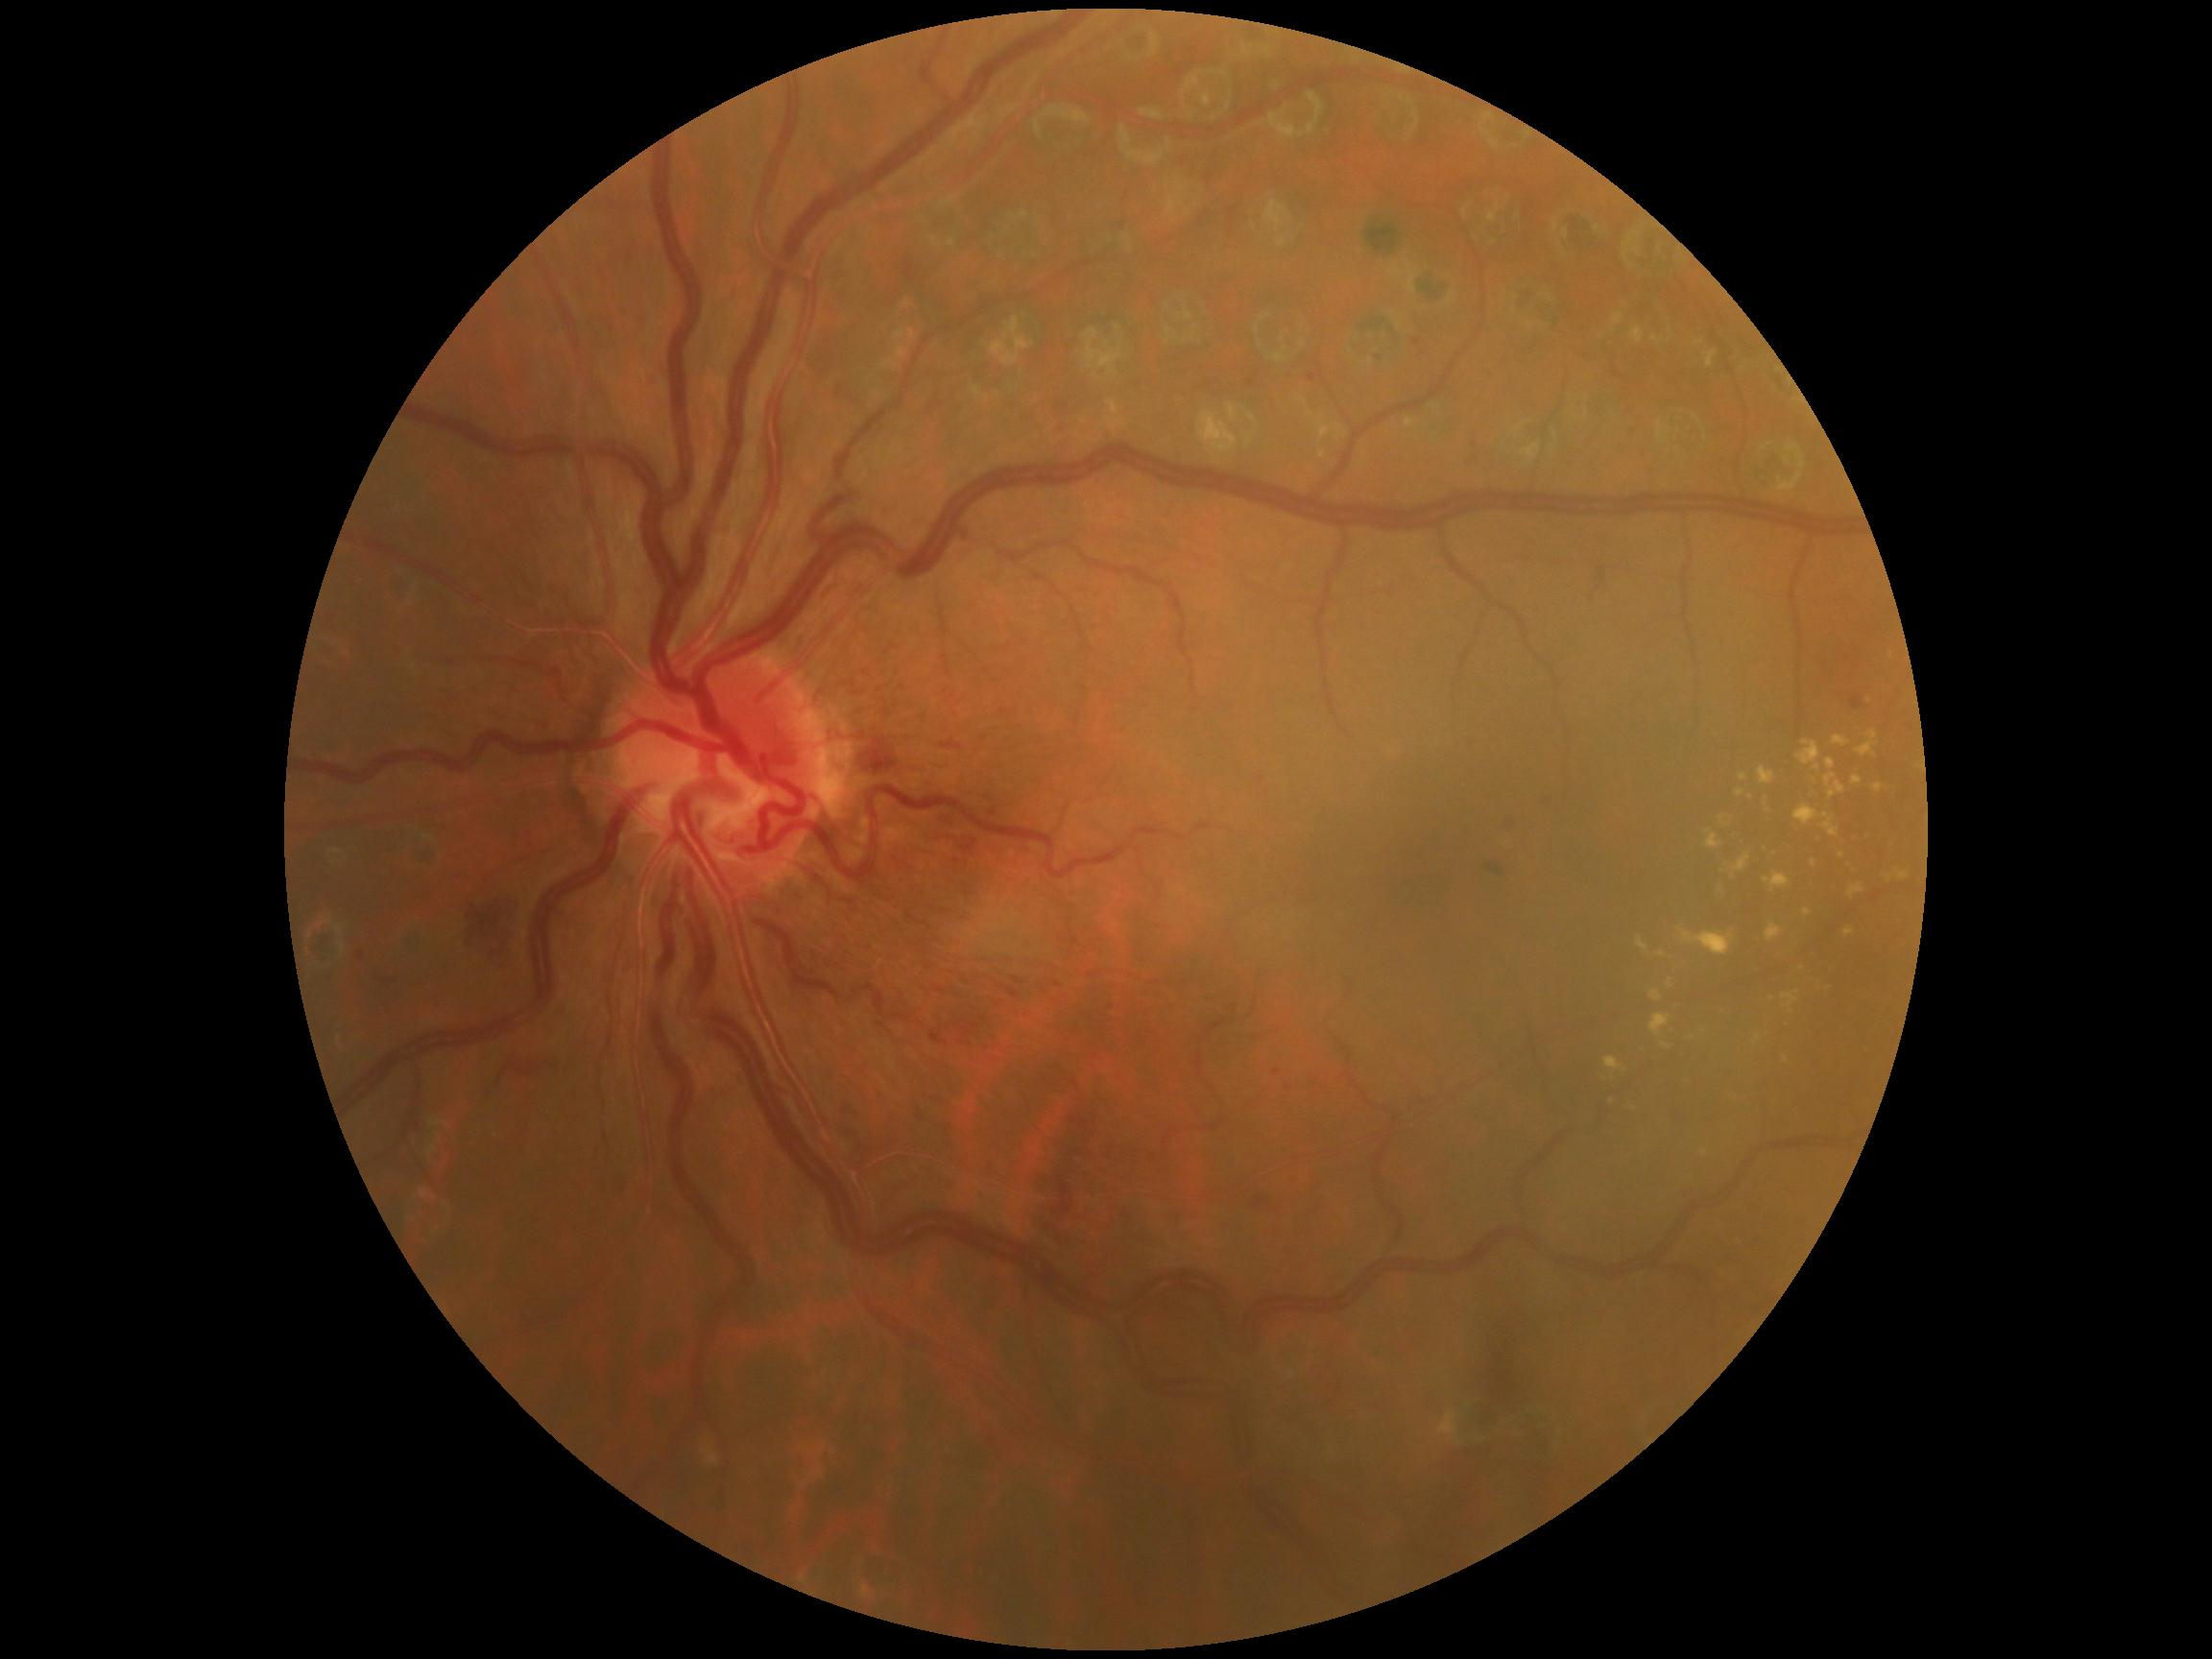
<lesions partial="true">
  <dr_grade>2</dr_grade>
  <ex partial="true">(x1=1782, y1=992, x2=1801, y2=1014), (x1=1758, y1=767, x2=1775, y2=786), (x1=1650, y1=1014, x2=1672, y2=1038), (x1=1844, y1=927, x2=1856, y2=939), (x1=1724, y1=854, x2=1751, y2=875), (x1=1805, y1=909, x2=1813, y2=918), (x1=1856, y1=730, x2=1880, y2=758), (x1=1719, y1=816, x2=1731, y2=828), (x1=1638, y1=937, x2=1650, y2=953), (x1=1736, y1=789, x2=1746, y2=797), (x1=1889, y1=653, x2=1894, y2=661), (x1=1739, y1=773, x2=1748, y2=782)</ex>
  <ex_small>[x=1723, y=872], [x=1815, y=782], [x=1768, y=810], [x=1635, y=1109], [x=1842, y=857]</ex_small>
  <he partial="true">(x1=841, y1=1102, x2=863, y2=1120), (x1=899, y1=259, x2=926, y2=288), (x1=930, y1=1032, x2=949, y2=1046), (x1=853, y1=733, x2=905, y2=777), (x1=1309, y1=362, x2=1326, y2=383), (x1=1588, y1=567, x2=1615, y2=605), (x1=1488, y1=866, x2=1503, y2=876), (x1=1495, y1=815, x2=1522, y2=837), (x1=488, y1=708, x2=502, y2=720), (x1=1008, y1=988, x2=1021, y2=999)</he>
  <he_small>[x=418, y=1126], [x=1260, y=779], [x=1475, y=445]</he_small>
</lesions>